Nonmydriatic. Color fundus photograph
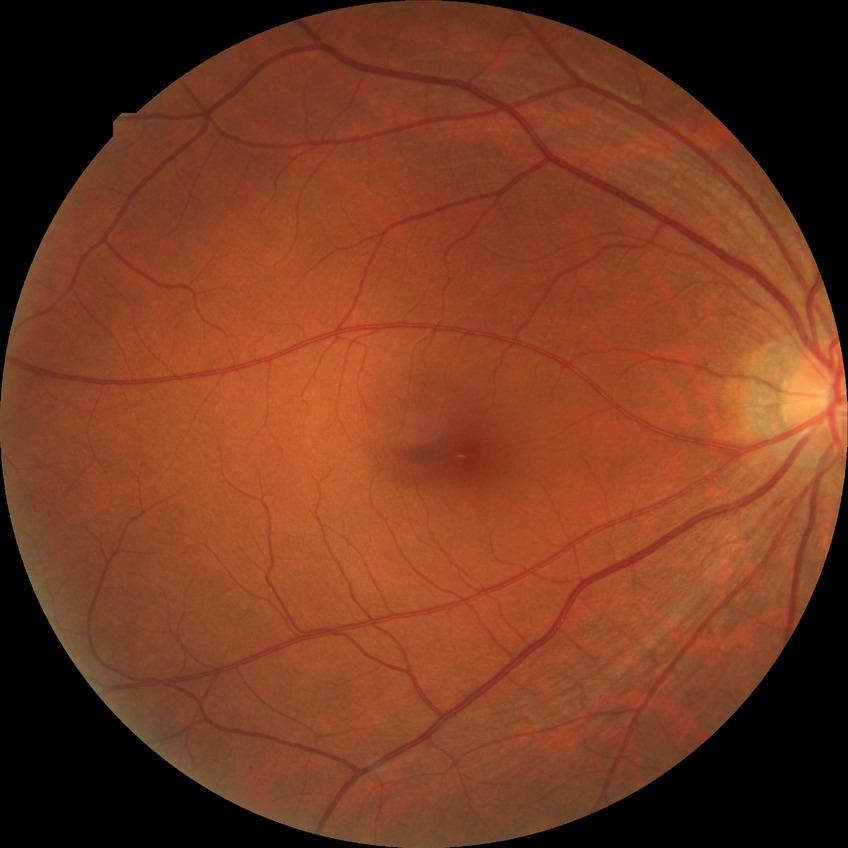
{"davis_grade": "no diabetic retinopathy"}